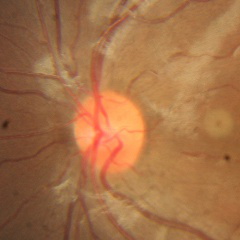
Diagnosis: no evidence of glaucoma.